Macula-centered field. Image size 2361x1568. Captured after pupil dilation. Color fundus image — 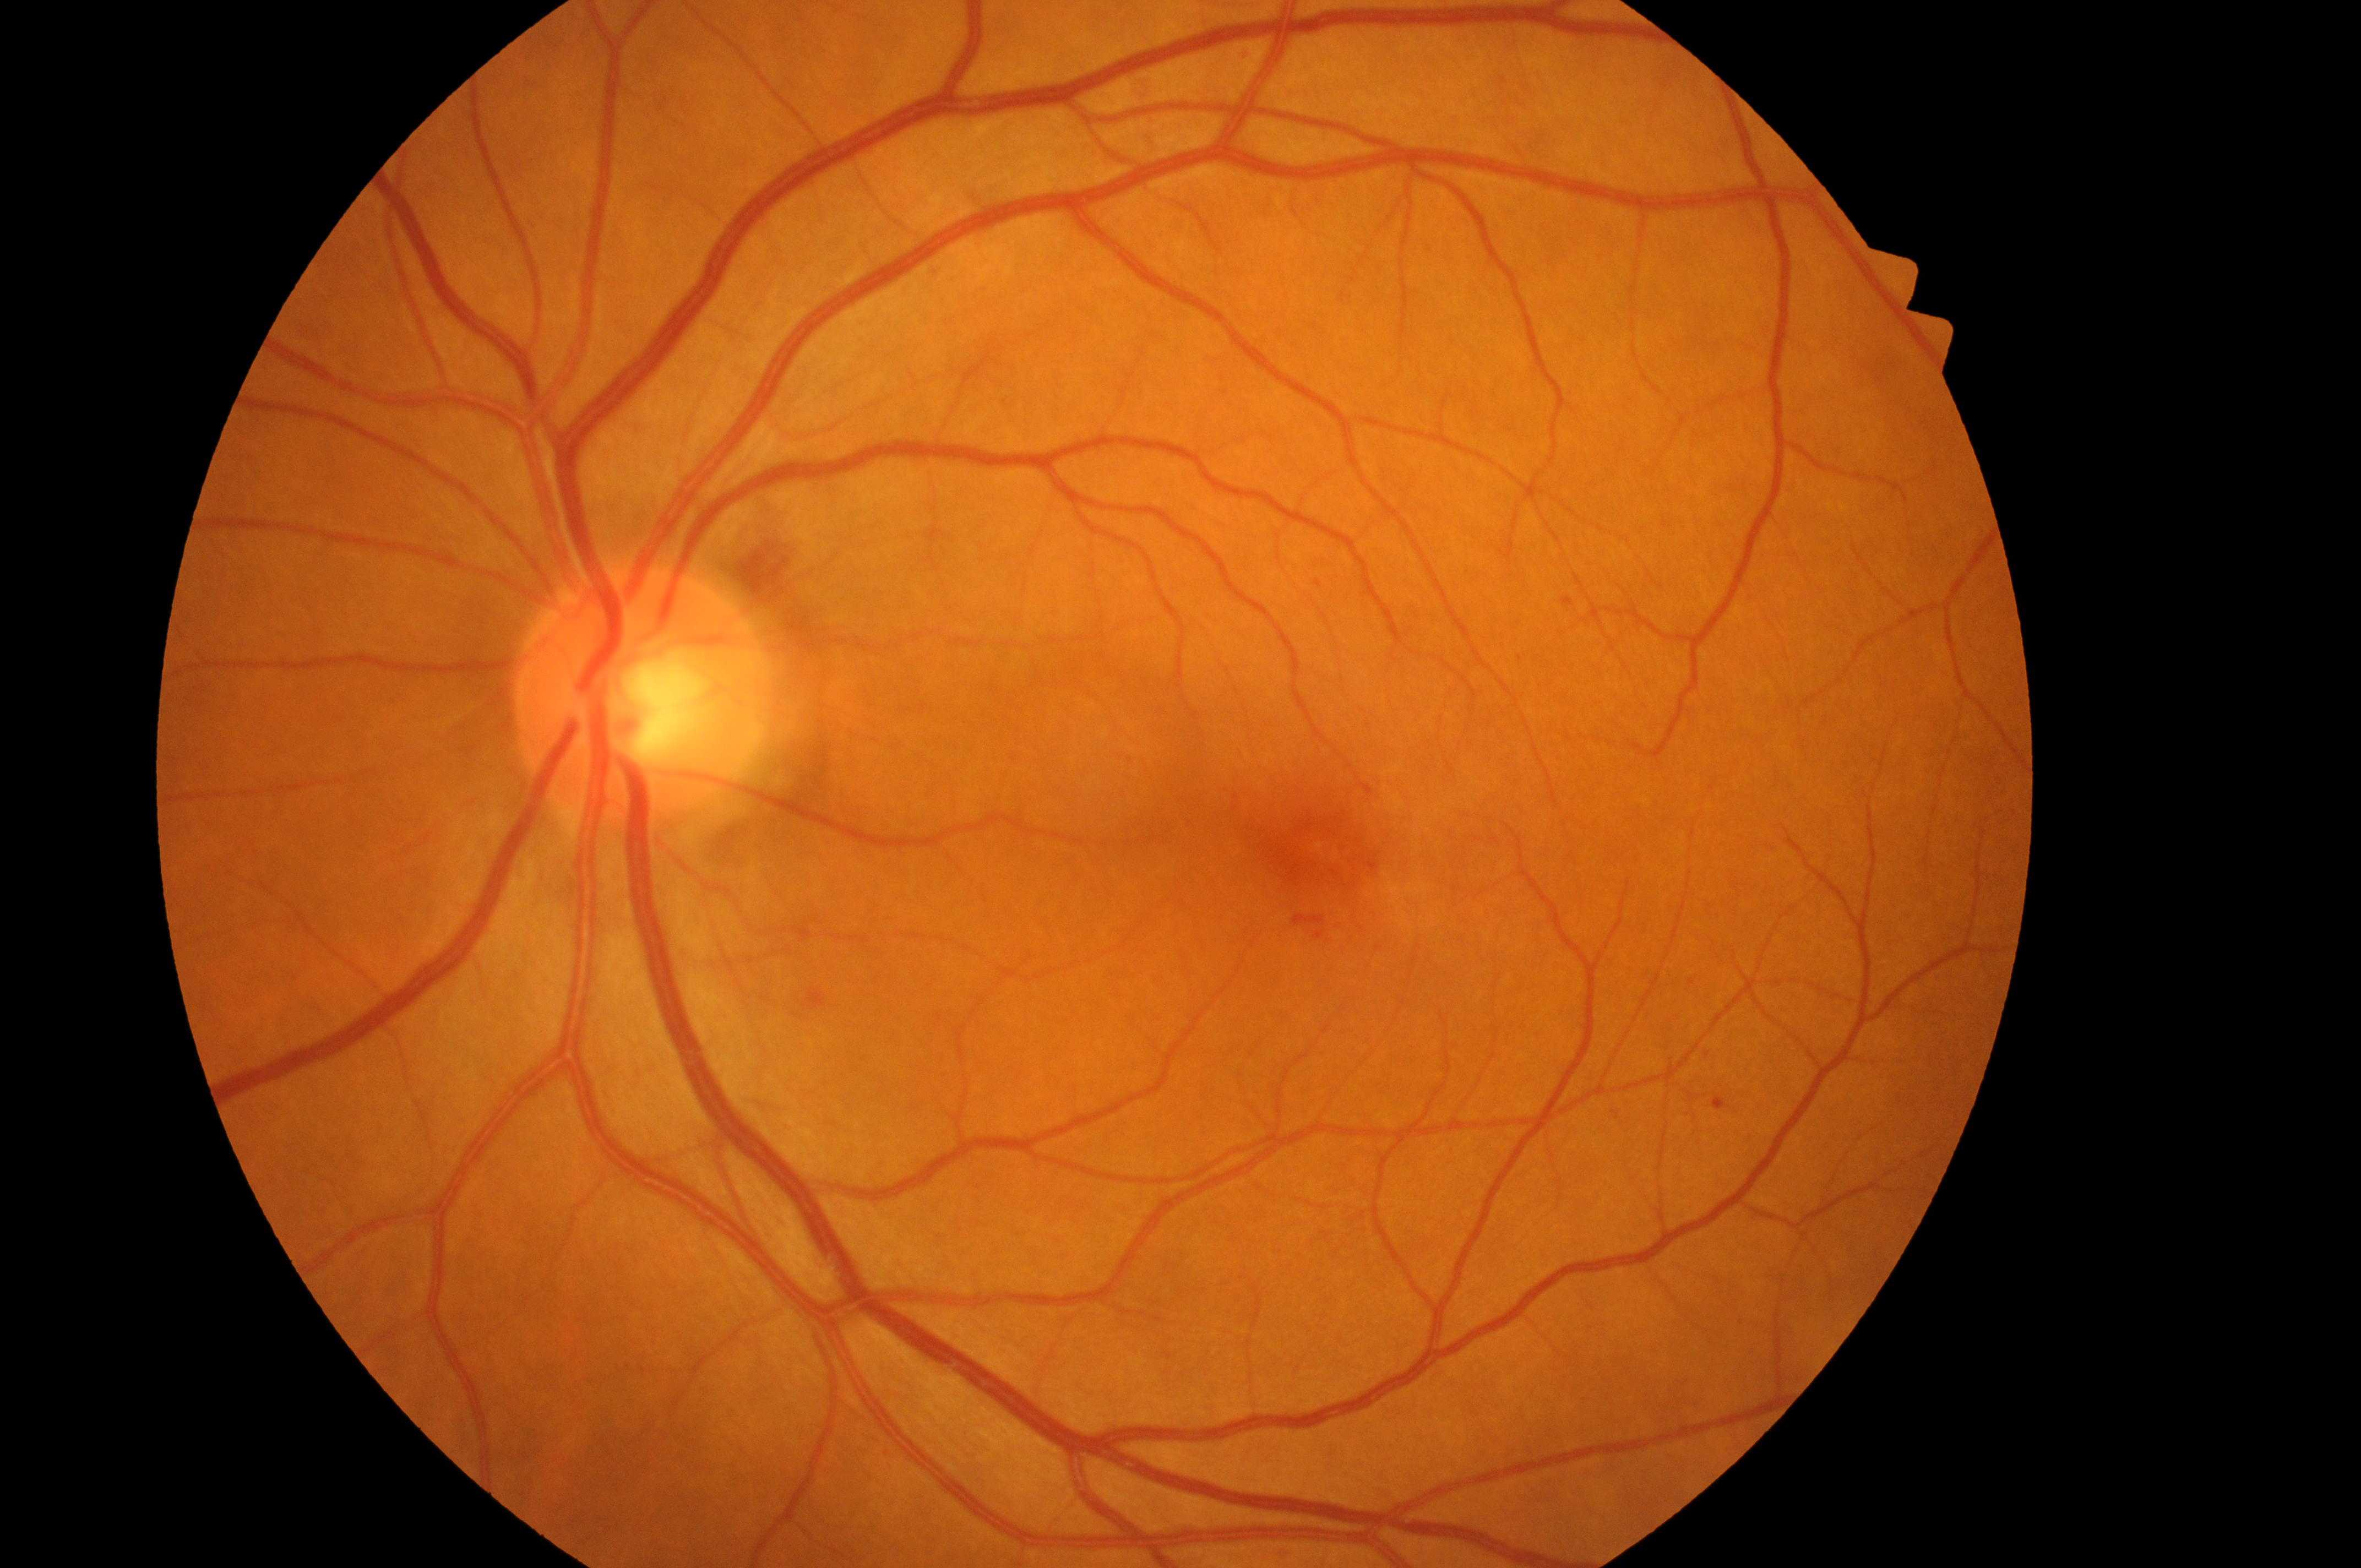
Optic nerve head: [635, 705]. Imaged eye: left eye. DR: 1. DME grade is 0. Macular center: [1320, 845].